Acquired with a Nidek AFC-330: 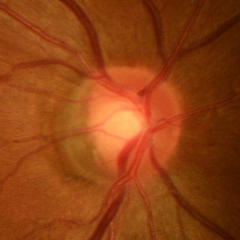
Assessment = early-stage glaucoma.